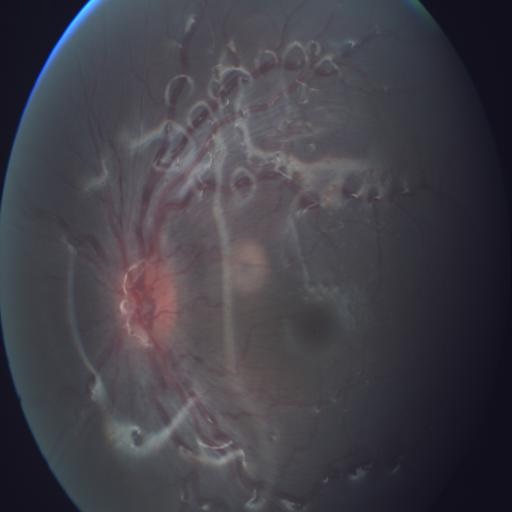

2 findings. The image shows tortuous vessels (TV) & optic disc edema (ODE).